DR severity per modified Davis staging: 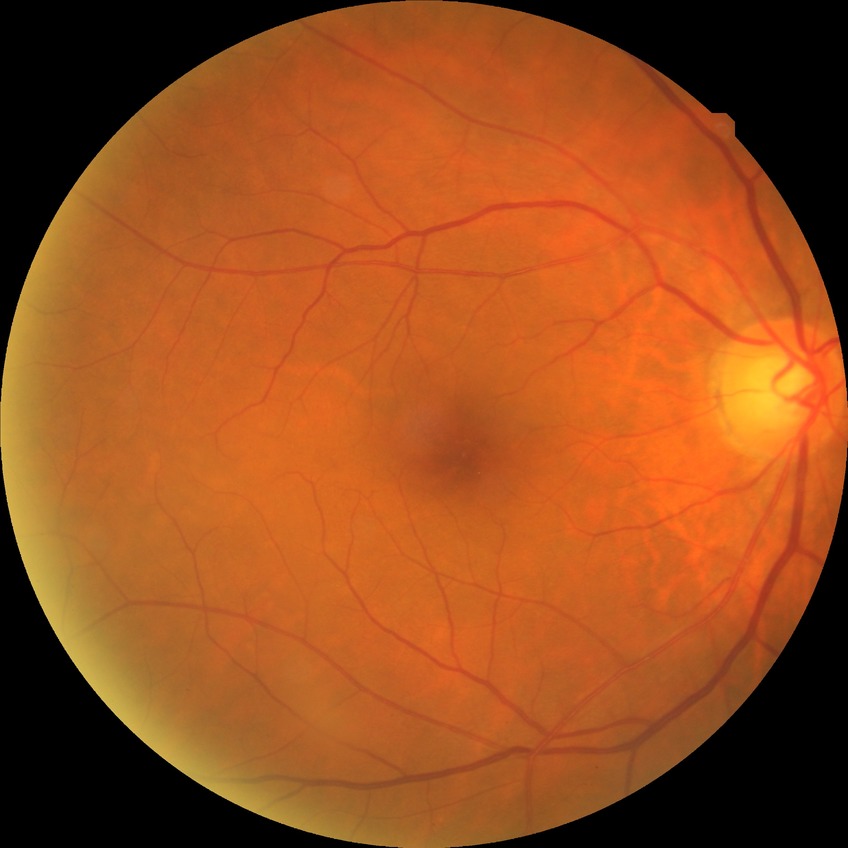 {"davis_grade": "no diabetic retinopathy"}